Mydriatic (tropicamide and phenylephrine)
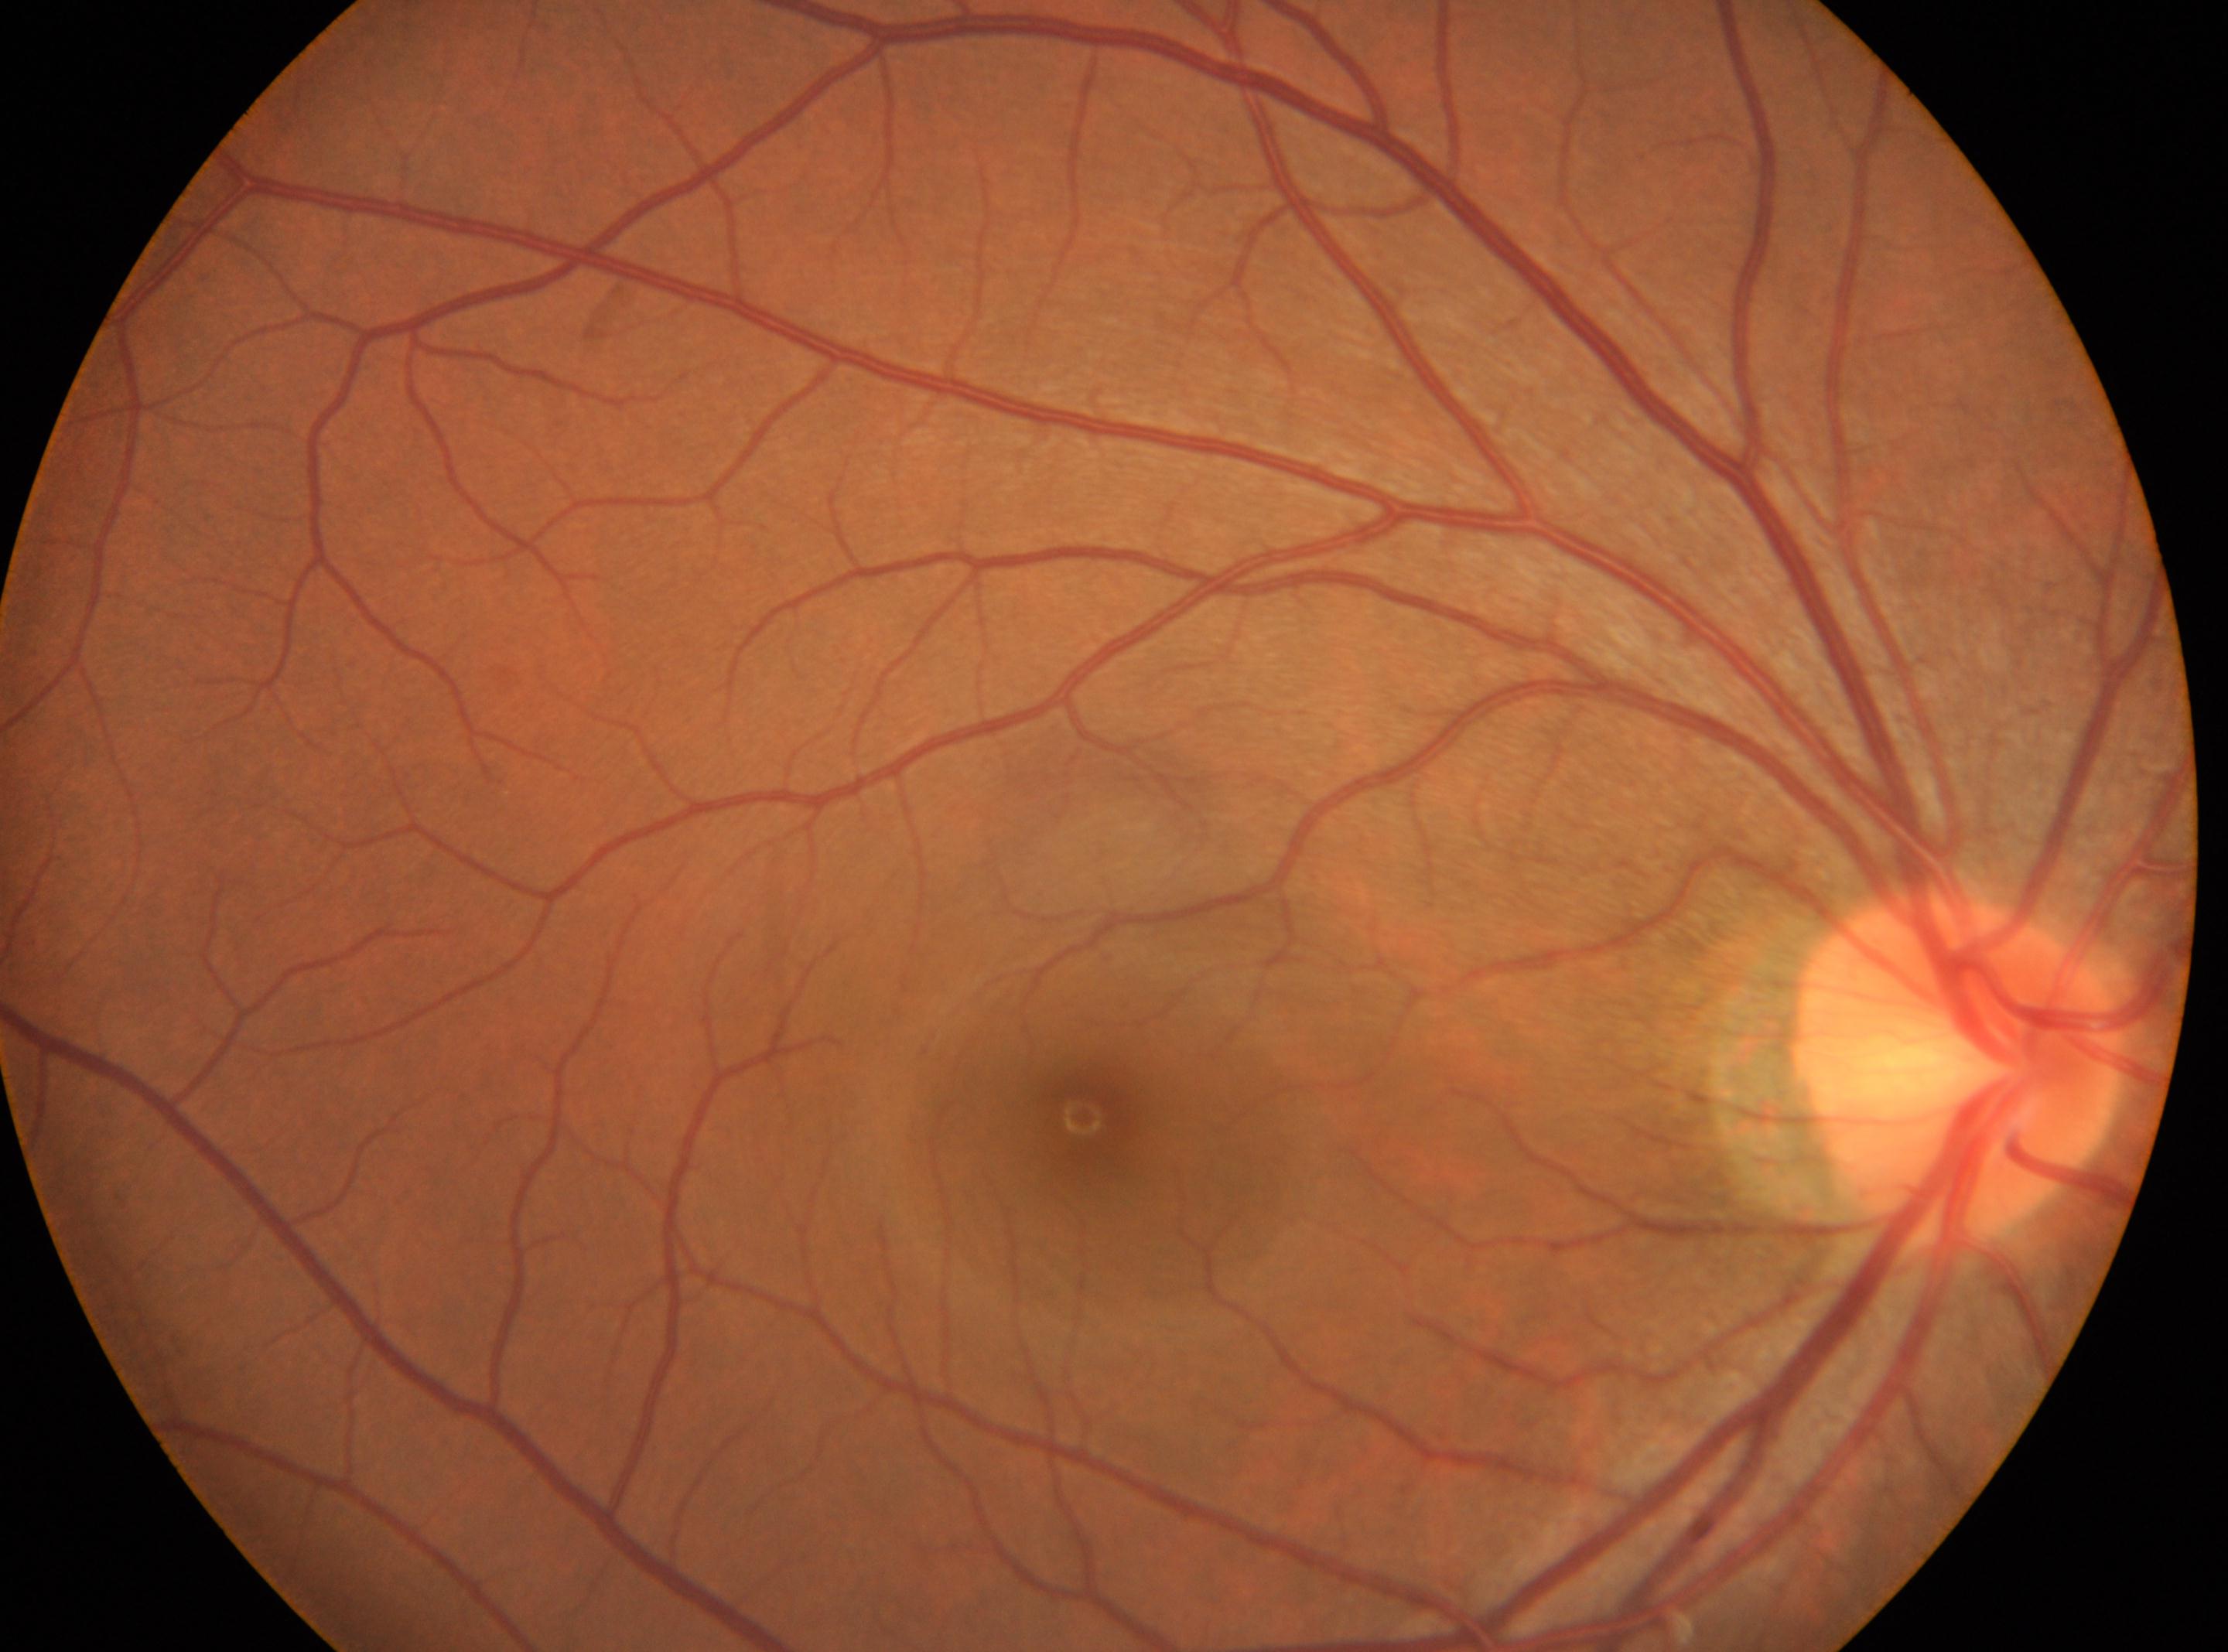 Findings:
- optic nerve head — 1954px, 1070px
- DR impression — No diabetic retinopathy identified
- laterality — right eye
- fovea center — 1083px, 1117px
- retinopathy grade — 0